DR severity per modified Davis staging; 848x848px — 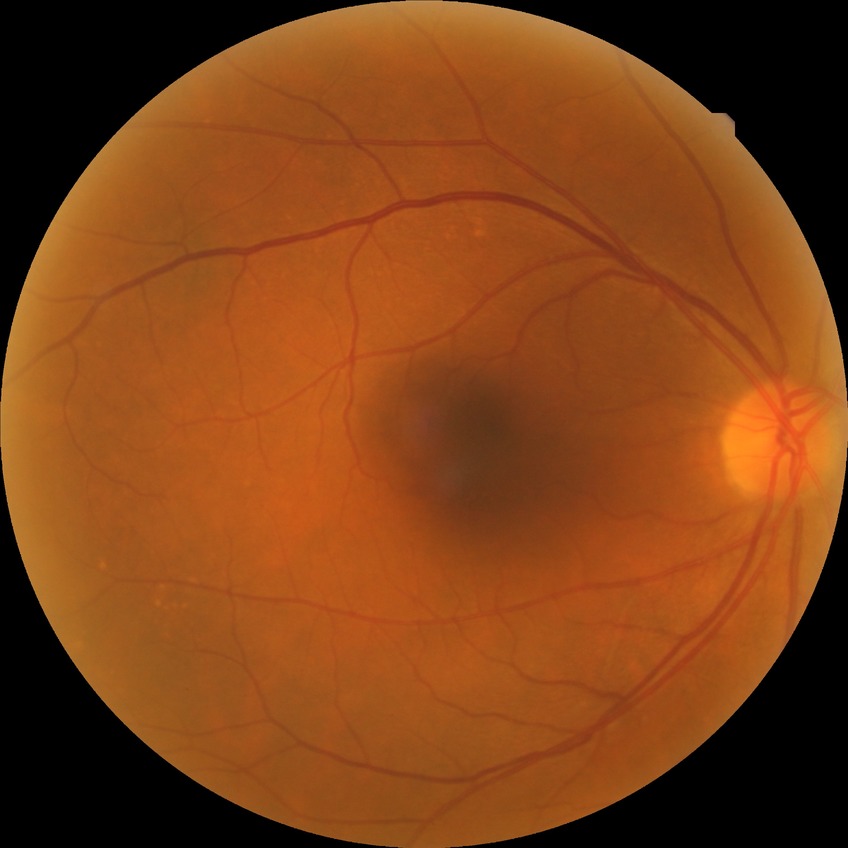
davis_grade: no diabetic retinopathy